848 x 848 pixels:
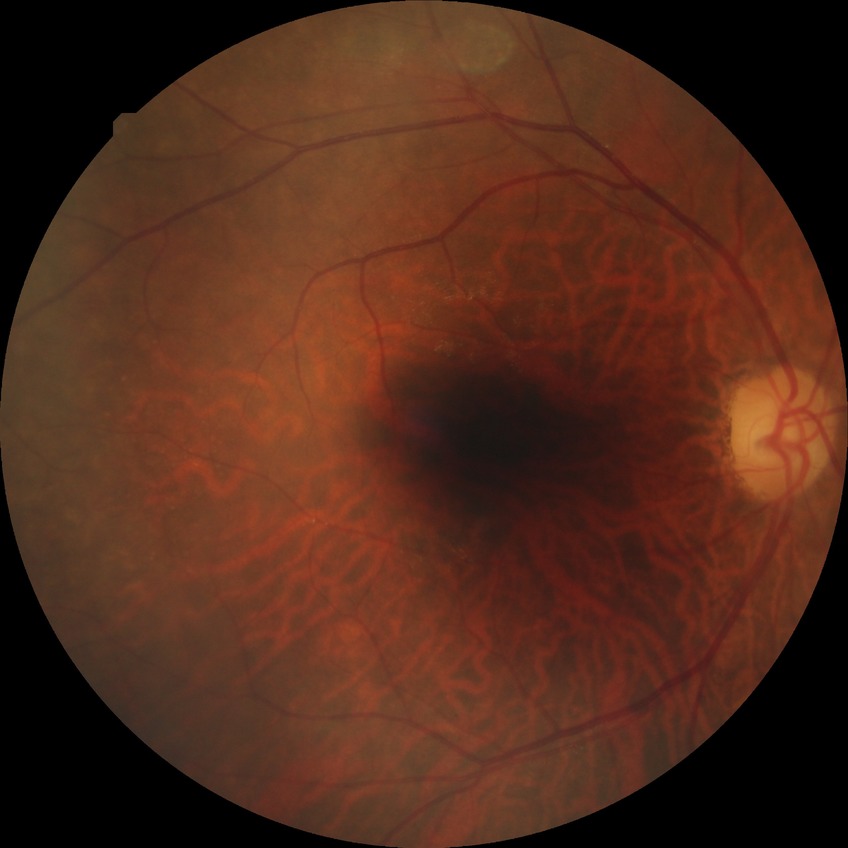
Diabetic retinopathy (DR) is no diabetic retinopathy (NDR).